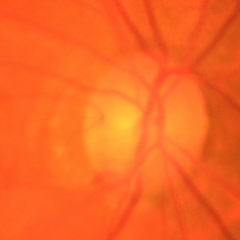 Assessment = early glaucoma.